Modified Davis grading, without pupil dilation — 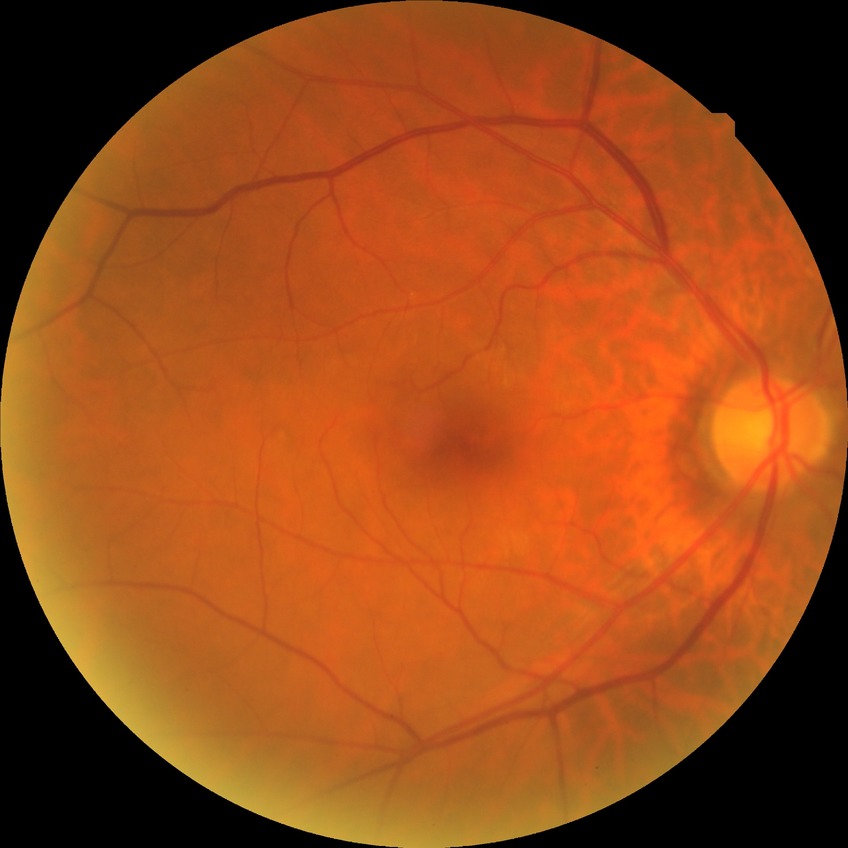
DR grade: NDR.
No signs of diabetic retinopathy.